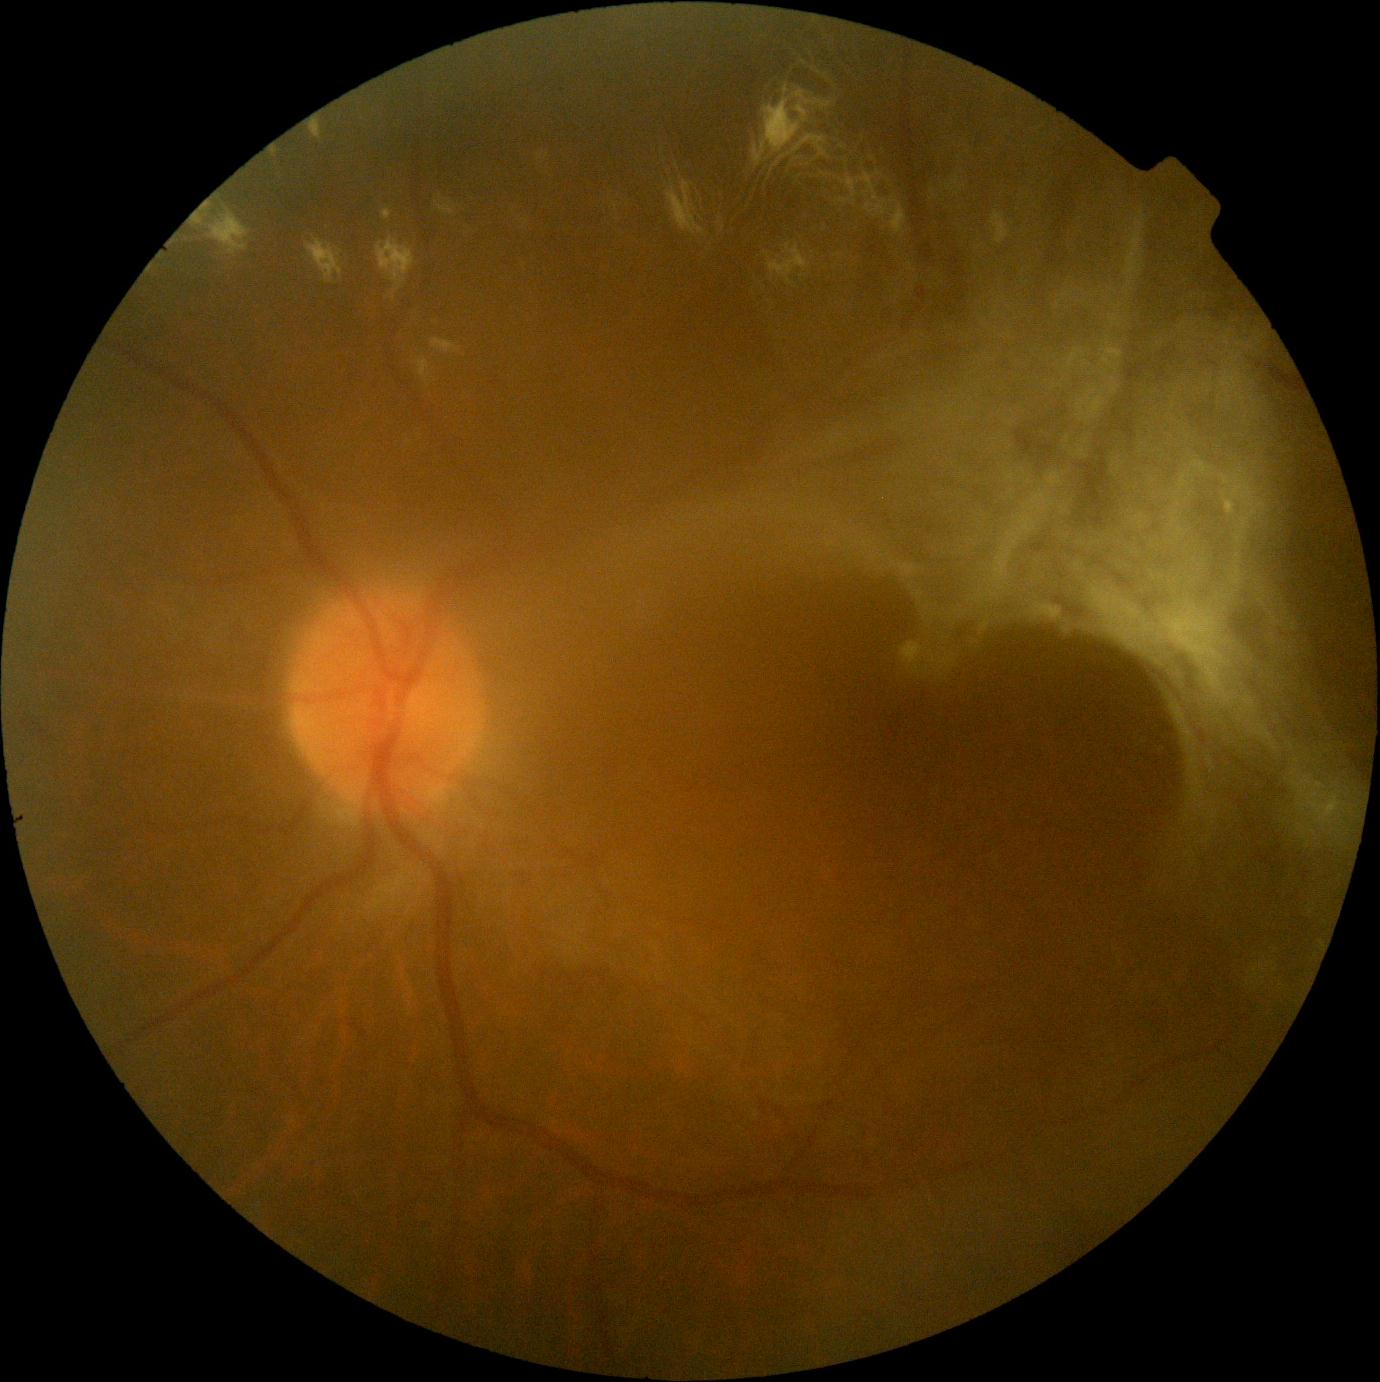

DR stage is 4.